Color fundus image · 45-degree field of view:
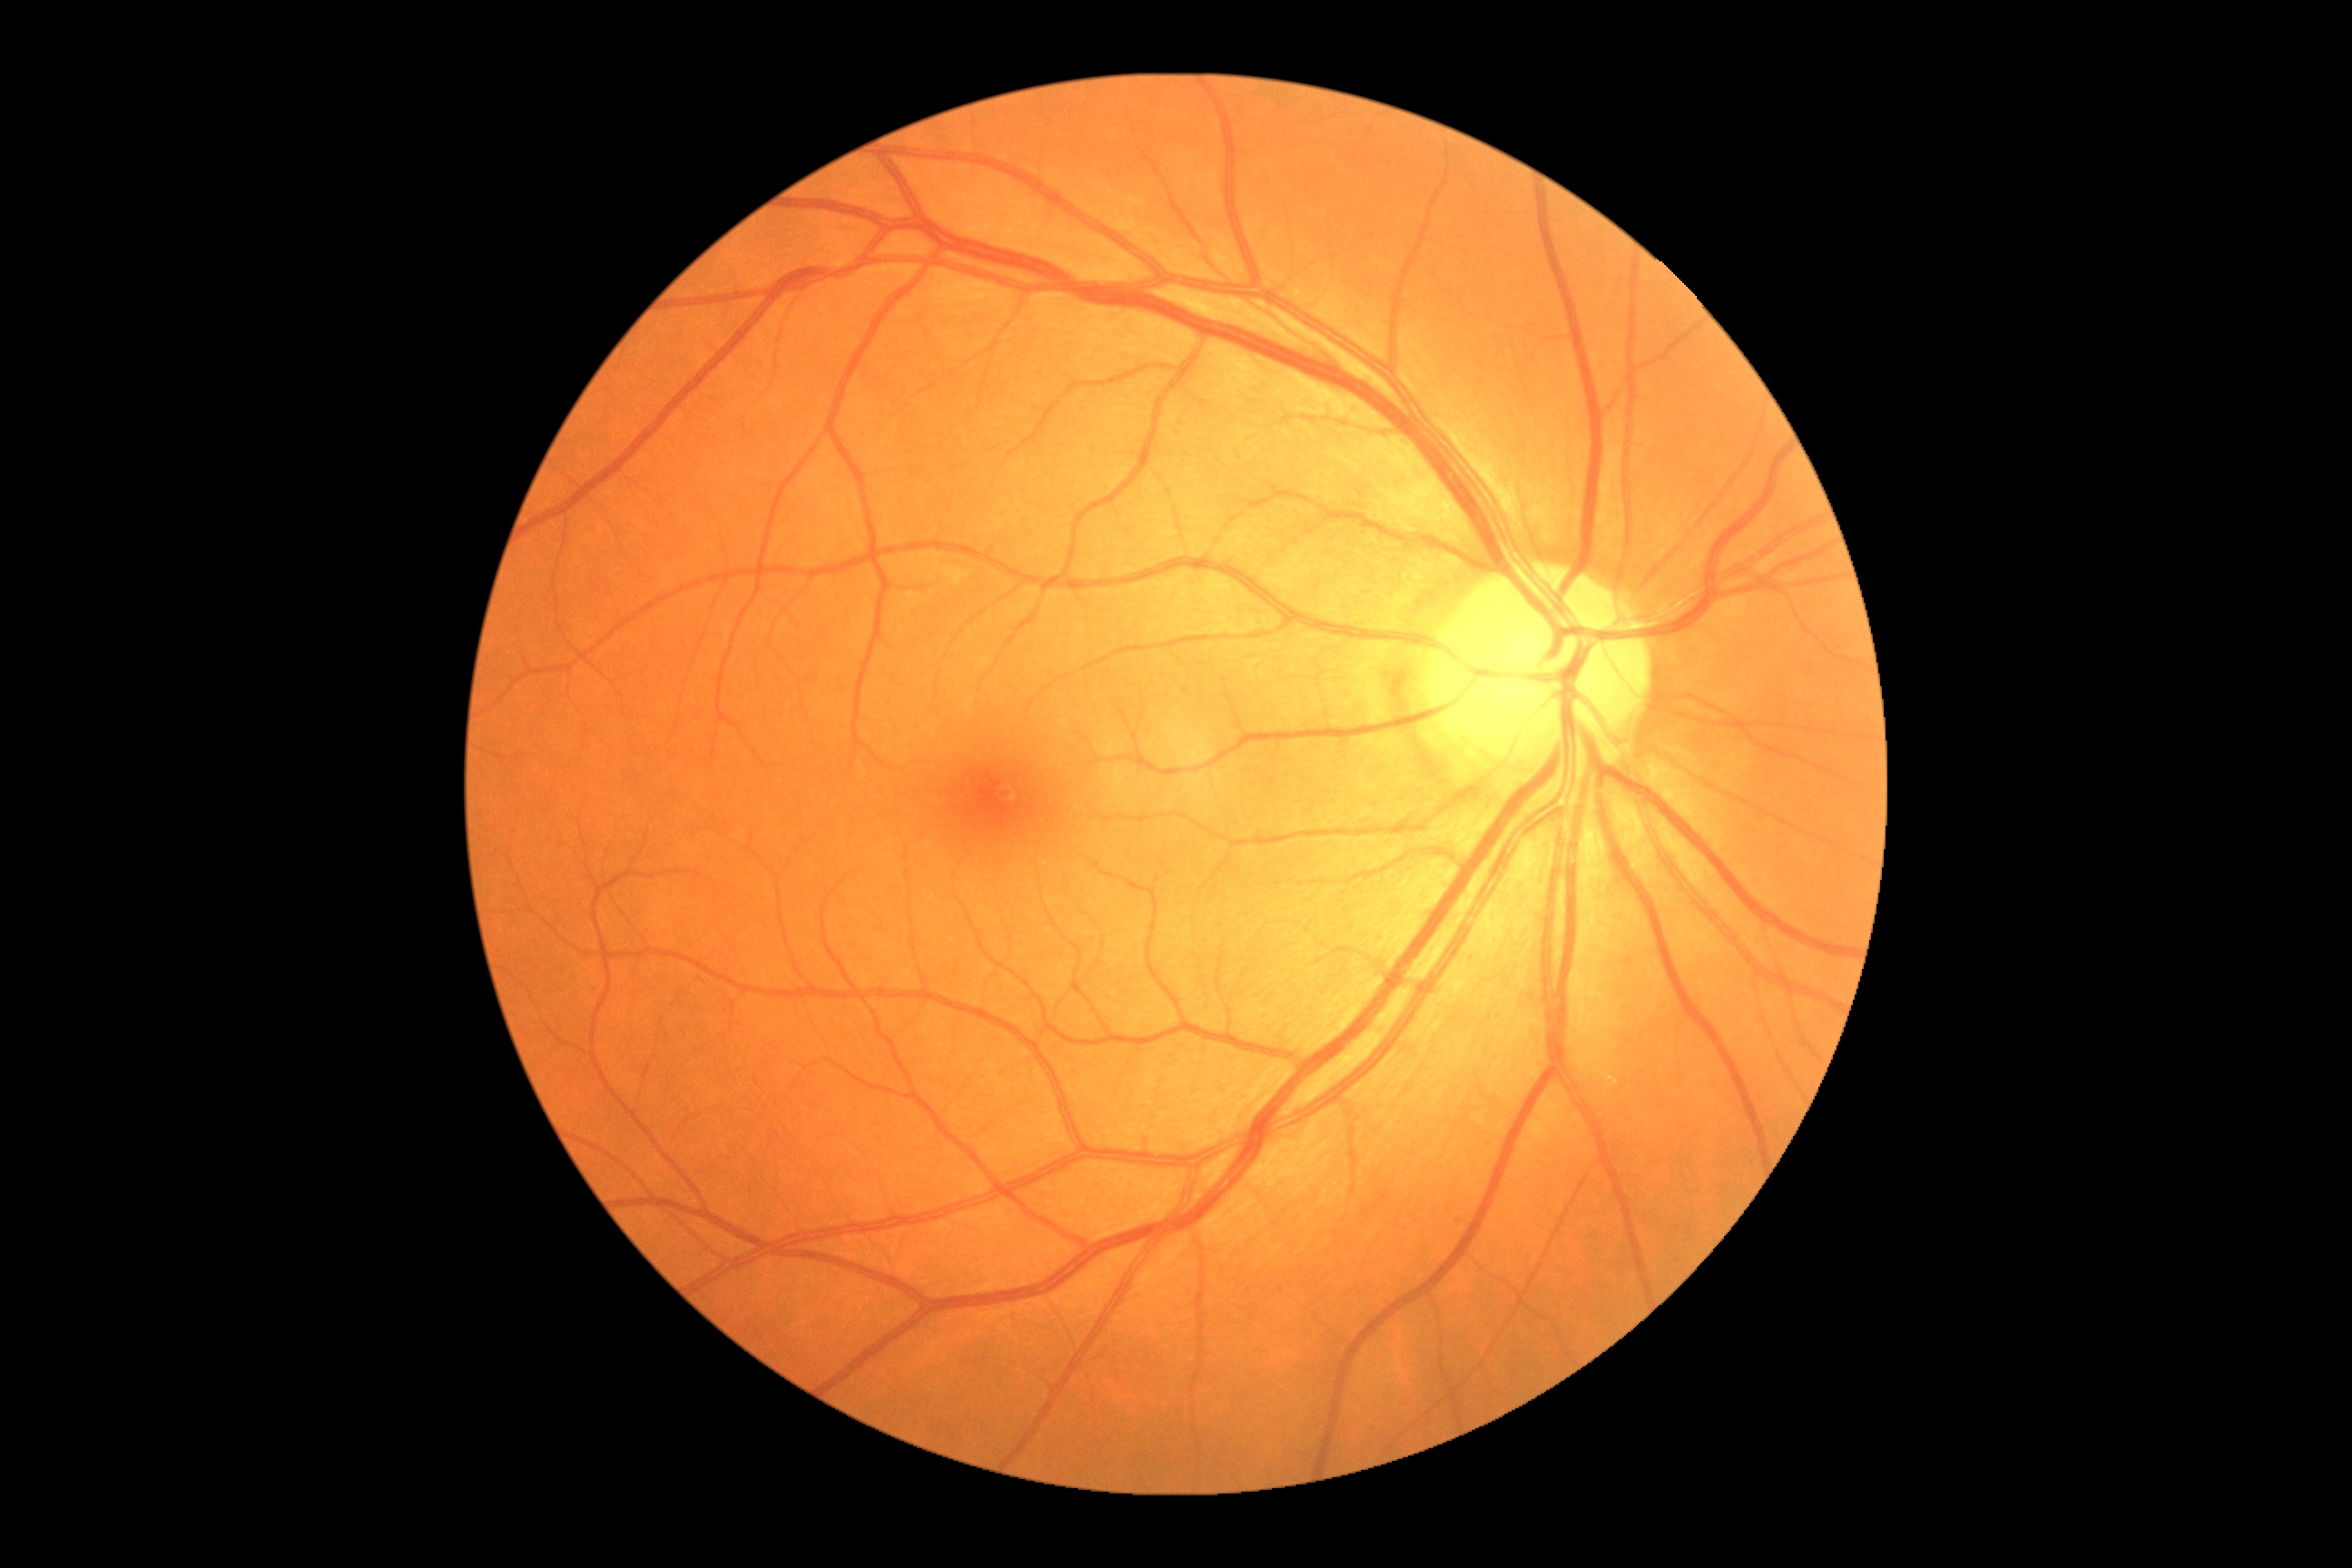

DR is grade 0.